Macula-centered field · dilated-pupil acquisition — 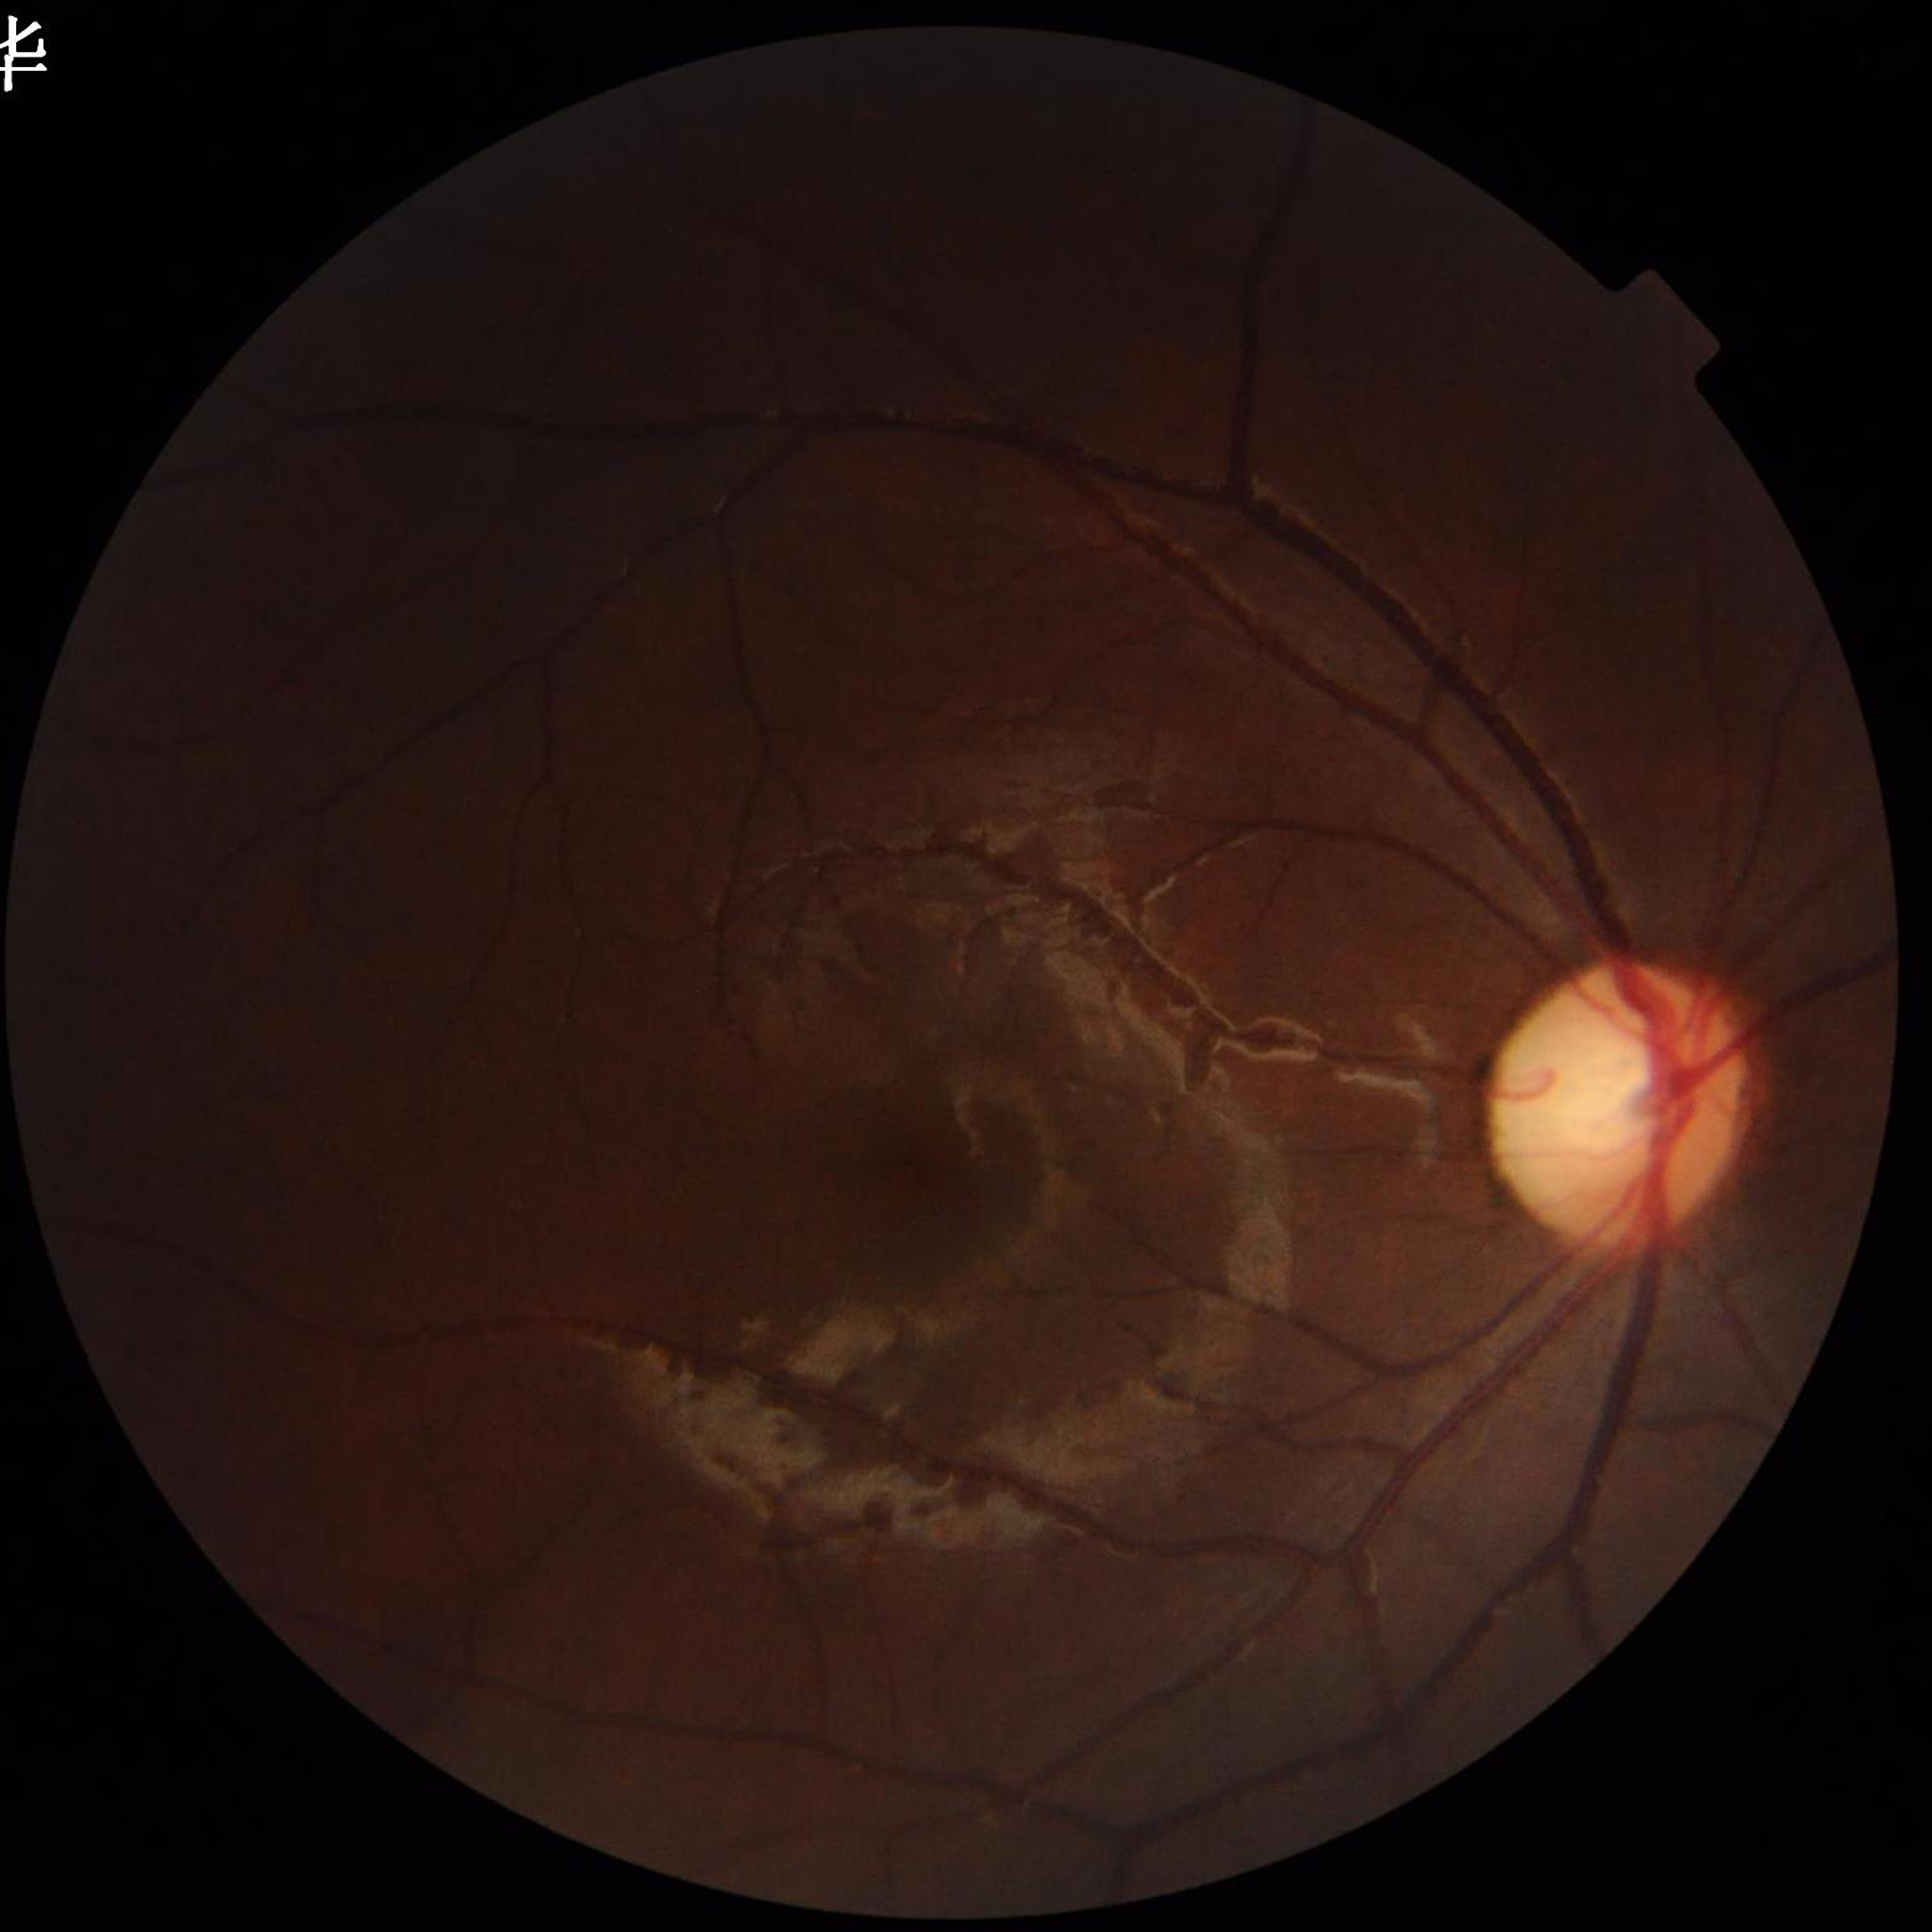 Diagnosis: no AMD, DR, or glaucomatous findings
Image quality: suboptimal — illumination/color distortion